Infant wide-field retinal image — 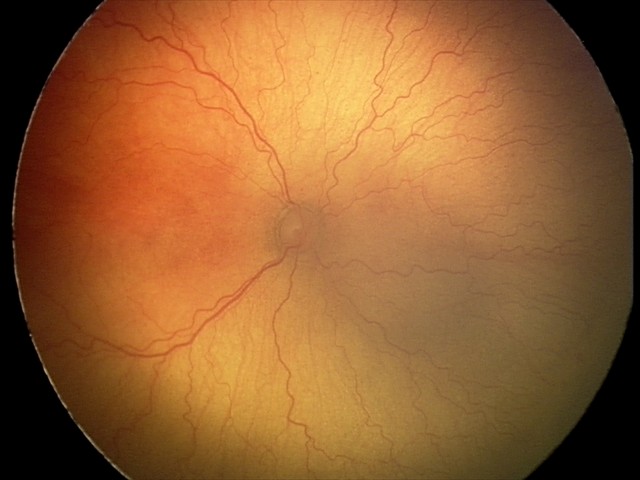
Assessment: aggressive retinopathy of prematurity.